Image size 2048x1536 · CFP.
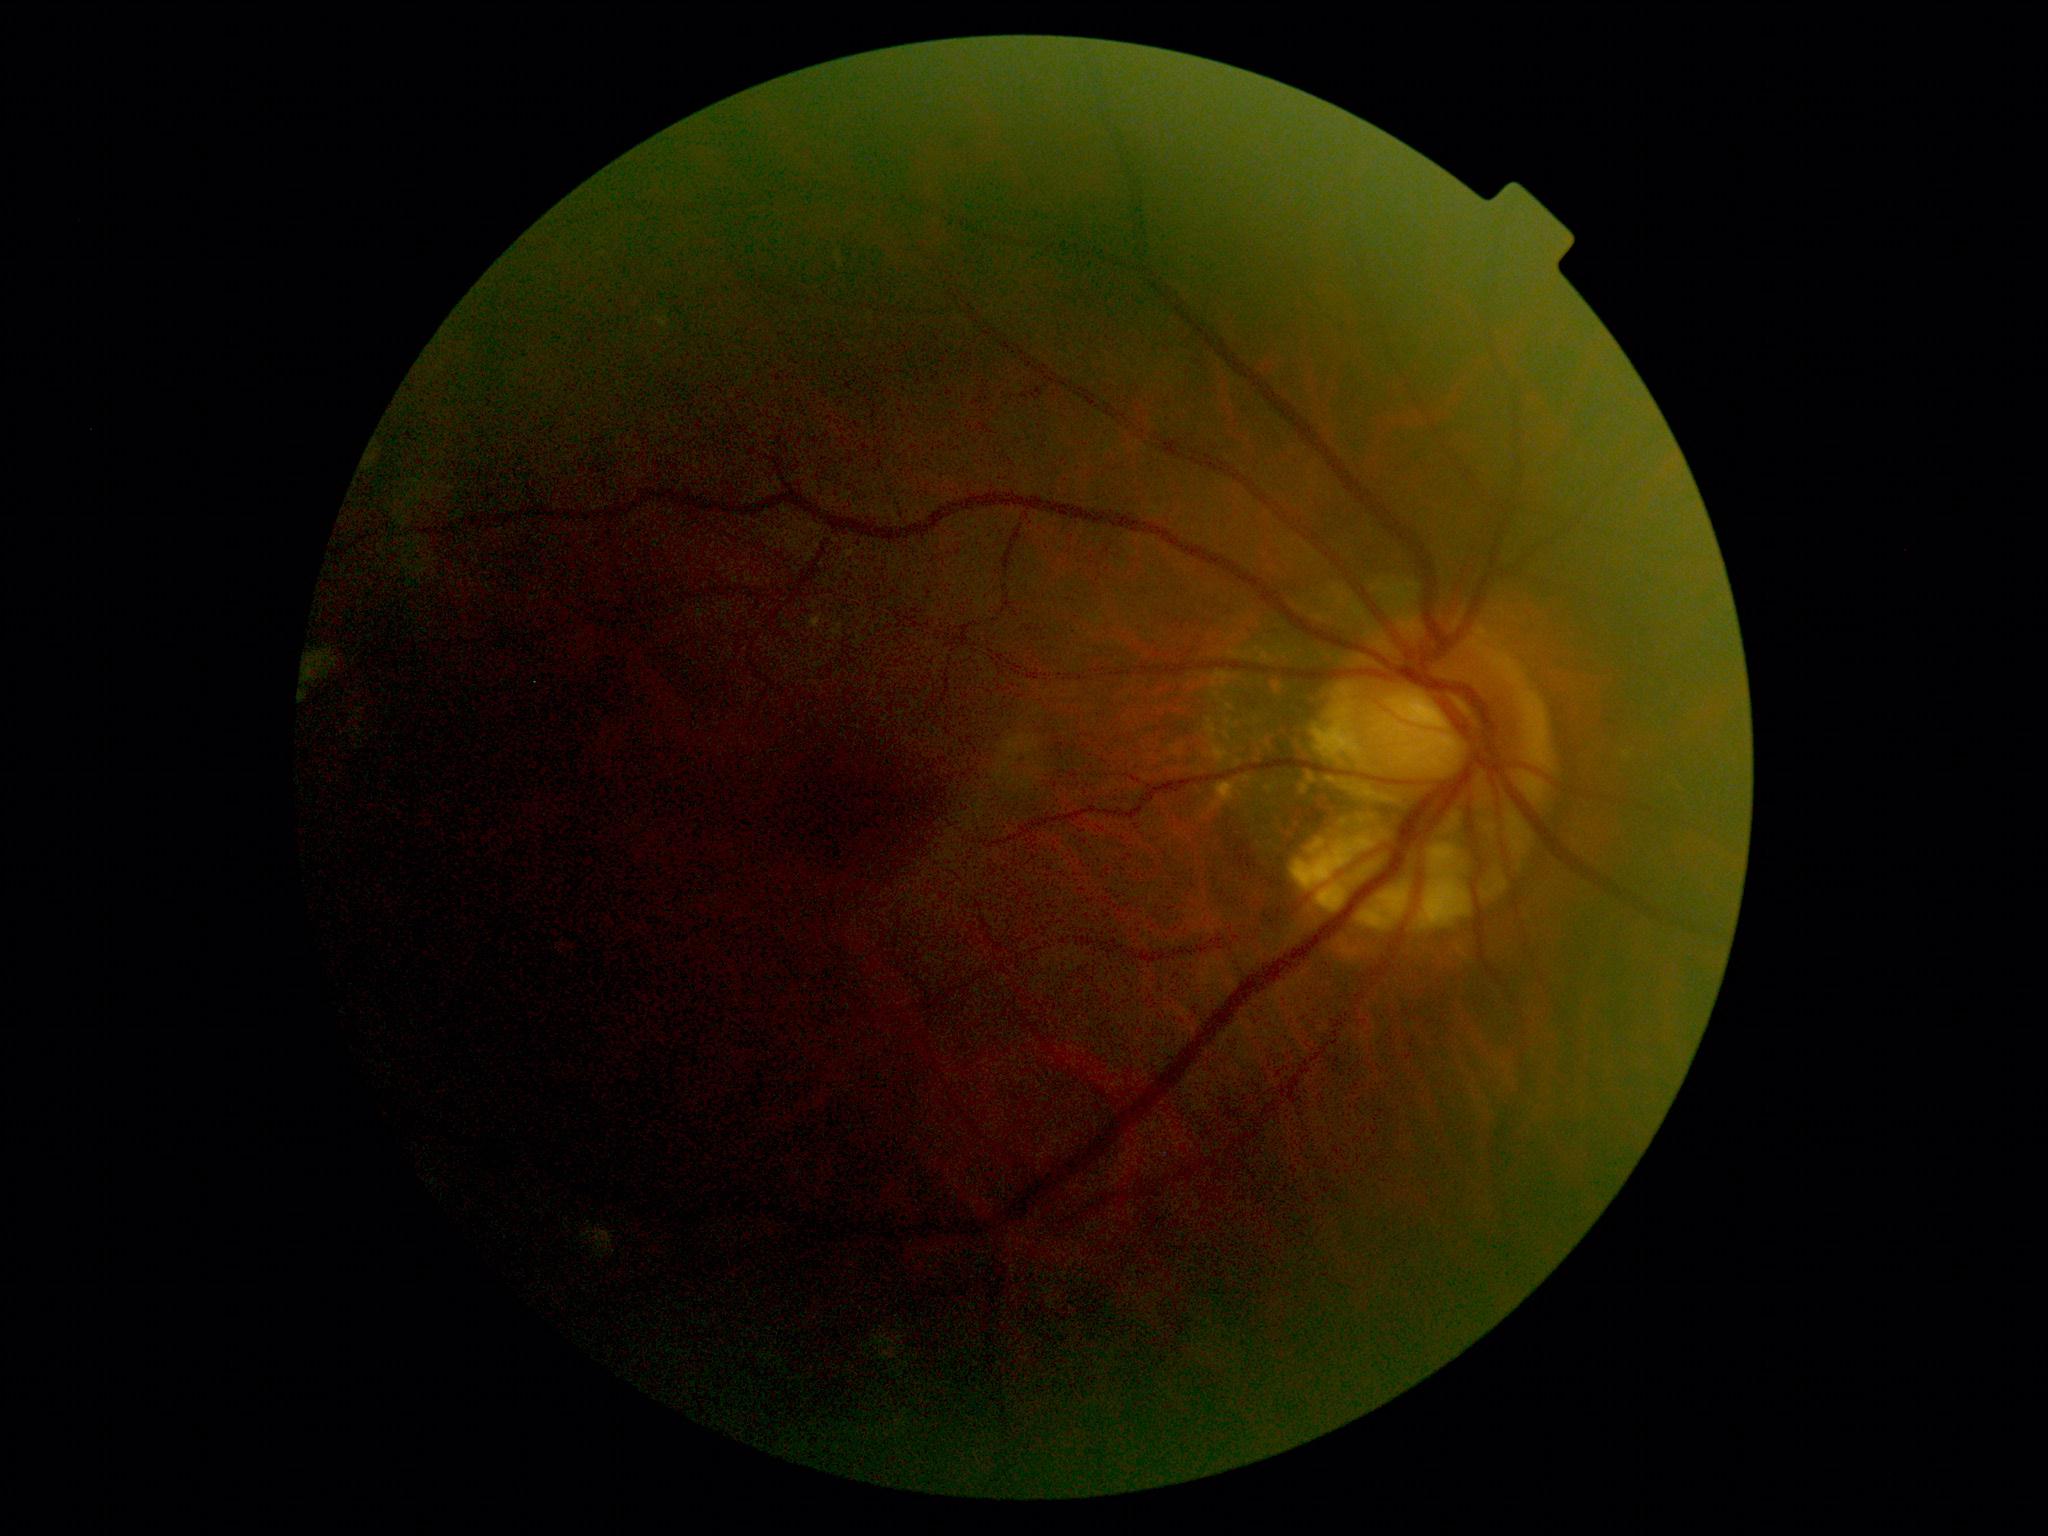
DR is grade 2 (moderate NPDR).